NIDEK AFC-230 fundus camera; 848x848px; retinal fundus photograph; nonmydriatic
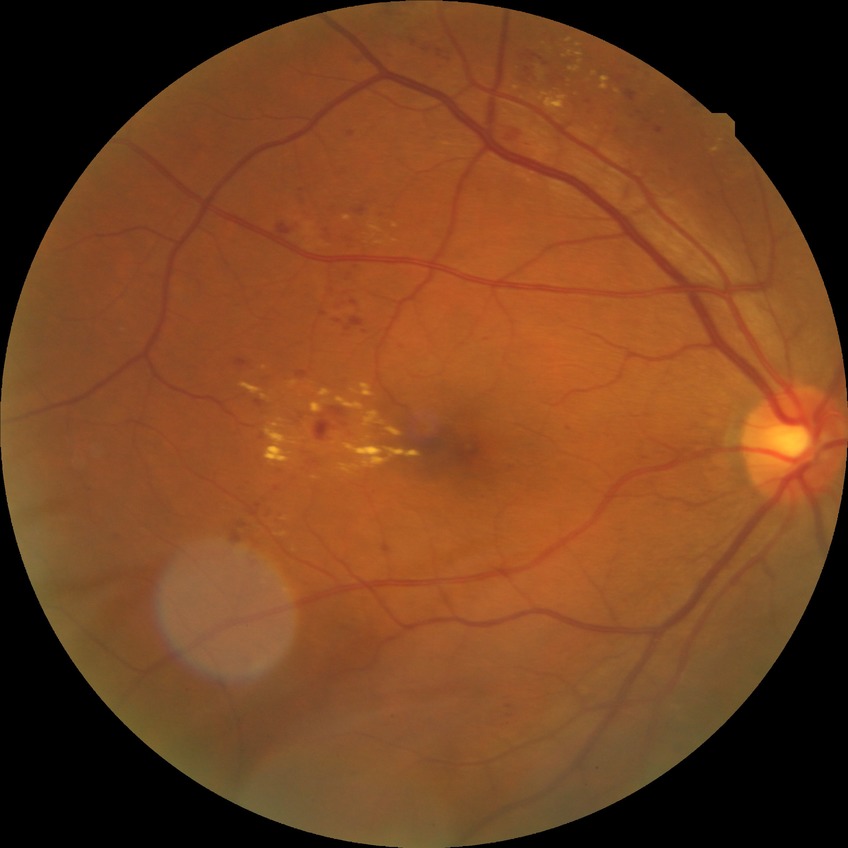
retinopathy grade: simple diabetic retinopathy, DR class: non-proliferative diabetic retinopathy.